50-degree field of view; captured on a Kowa VX-10α fundus camera: 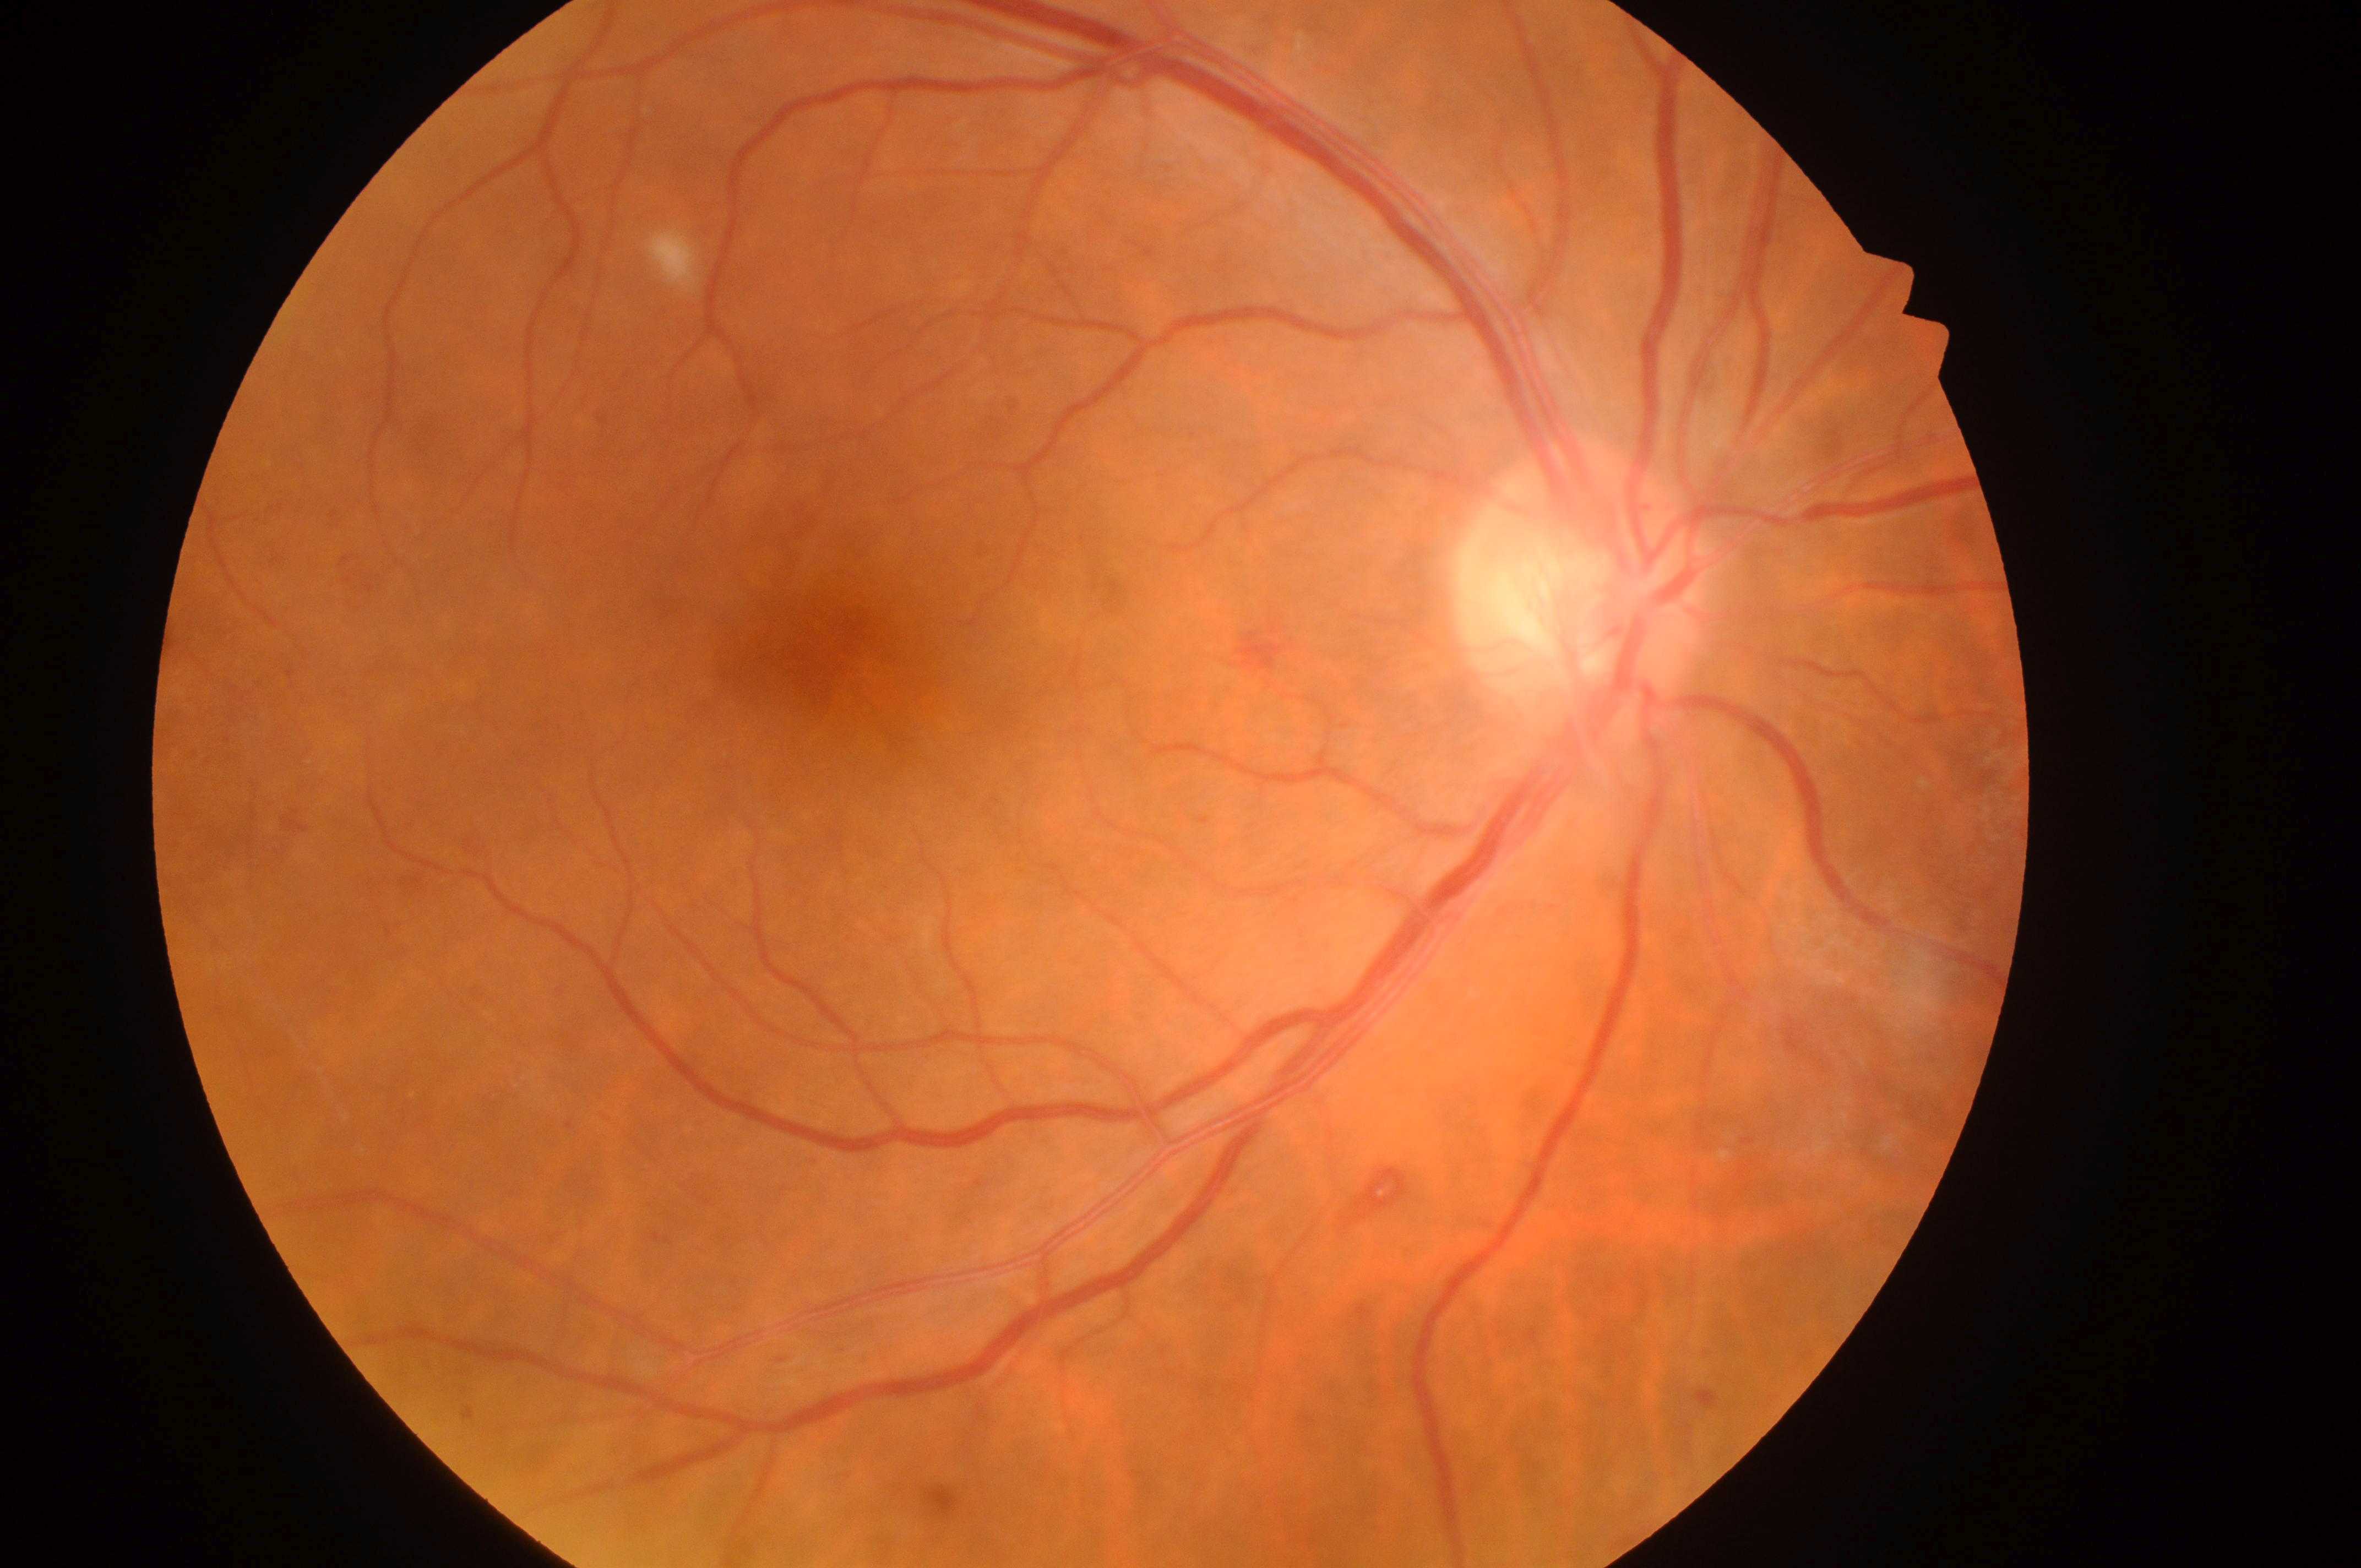
DR stage: moderate non-proliferative diabetic retinopathy (grade 2).
The optic disk is at (x: 1574, y: 602).
DME is grade 0 (no risk).
Eye: oculus dexter.
The macula center is at (x: 813, y: 655).